Fundus photo — 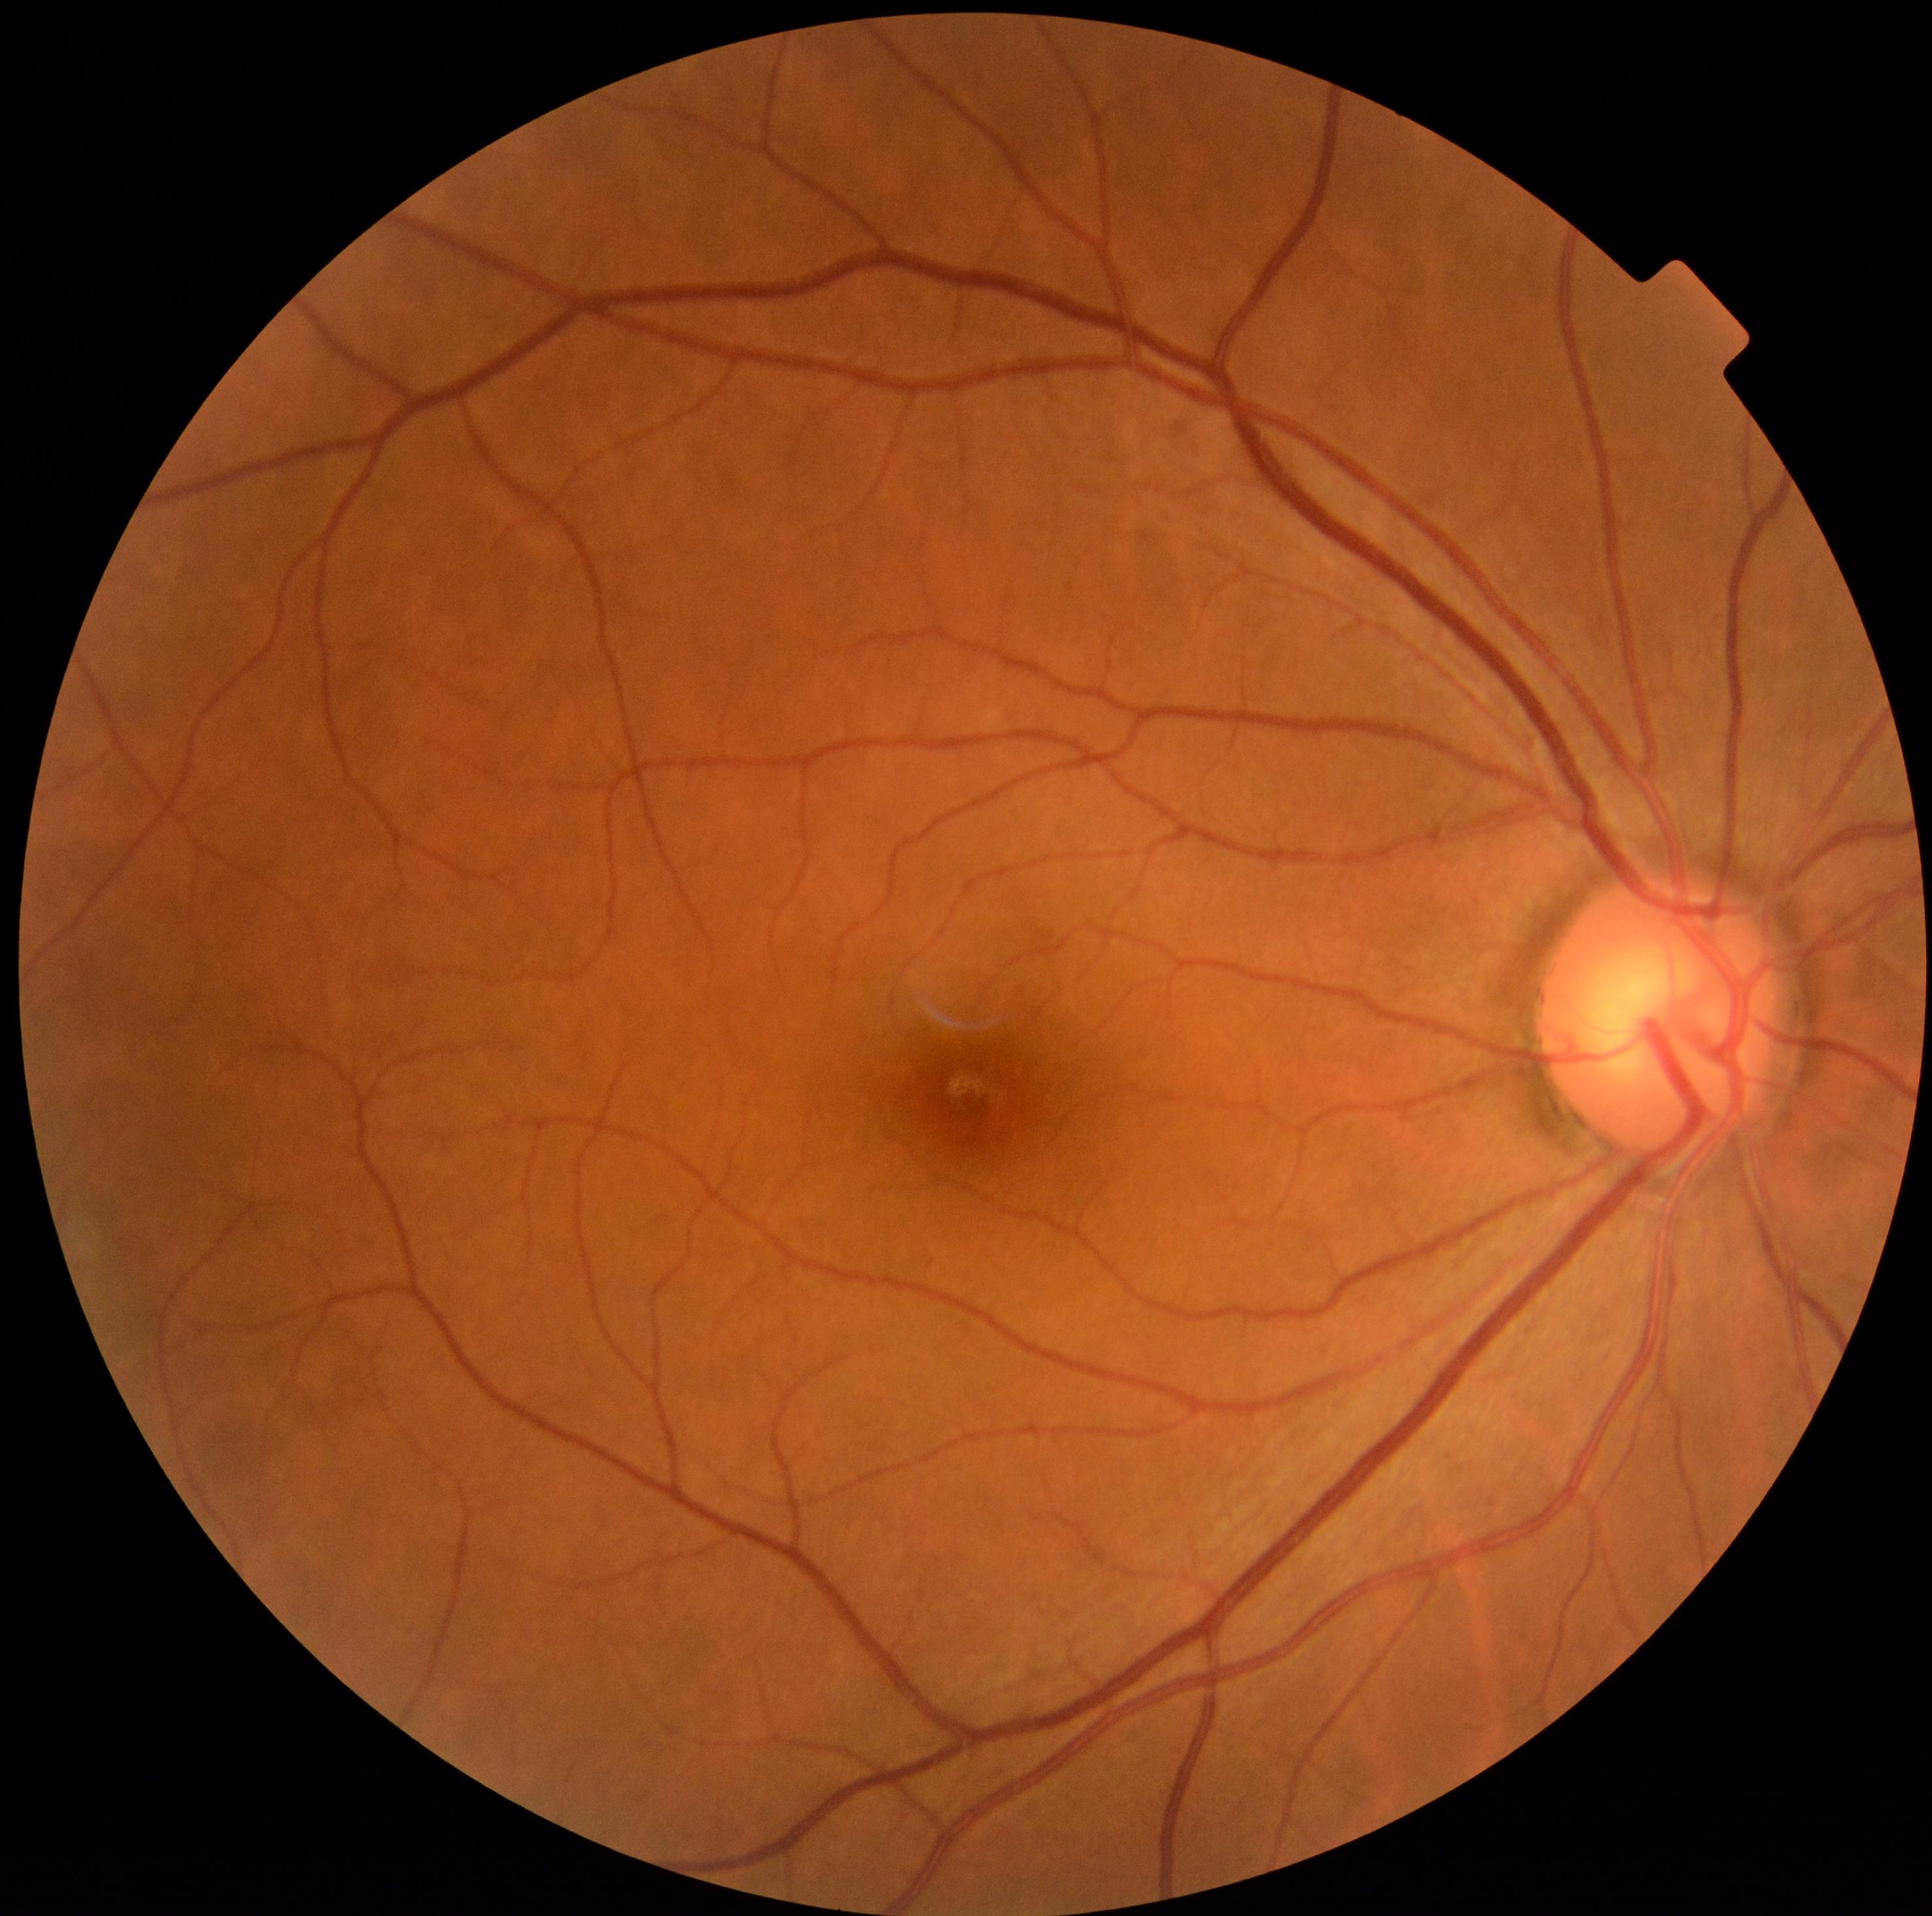

- DR impression — no DR findings
- DR — no apparent retinopathy (grade 0) — no visible signs of diabetic retinopathy